Pediatric retinal photograph (wide-field). Image size 640x480. Camera: Clarity RetCam 3 (130° FOV) — 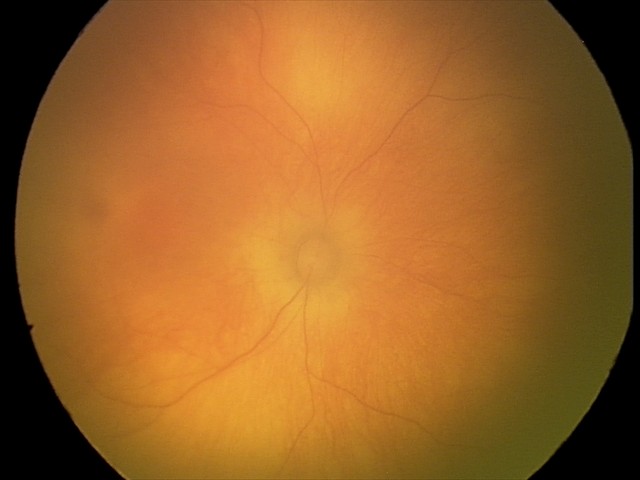
Diagnosis = physiological